848x848px. Modified Davis classification. Acquired with a NIDEK AFC-230. Nonmydriatic fundus photograph. 45 degree fundus photograph.
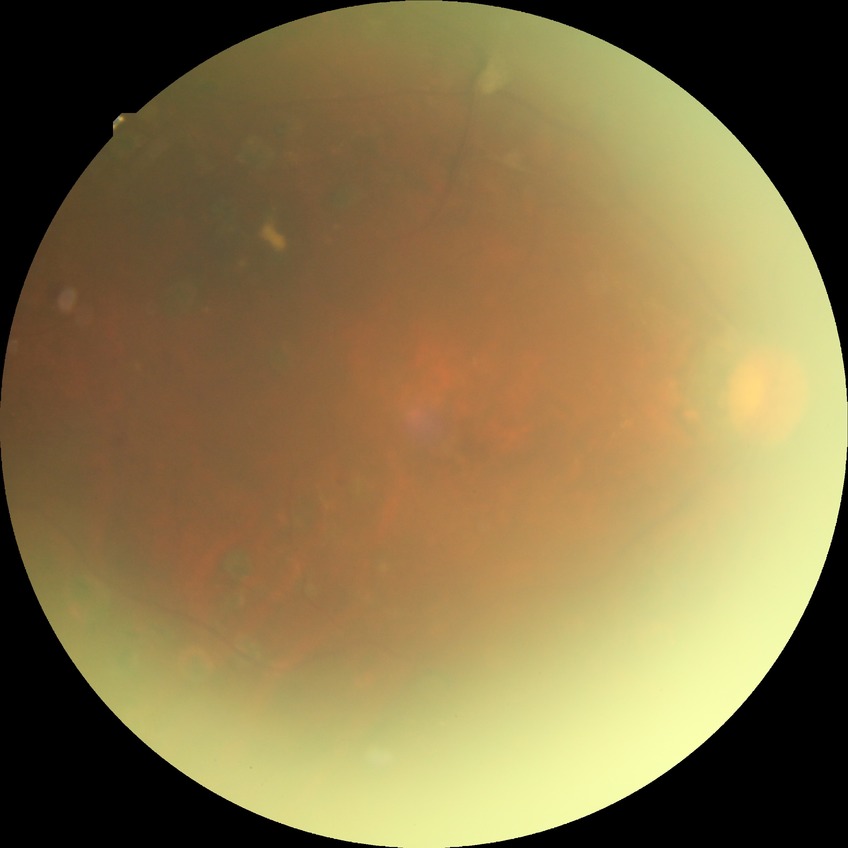
Annotations:
- modified Davis grade — PDR